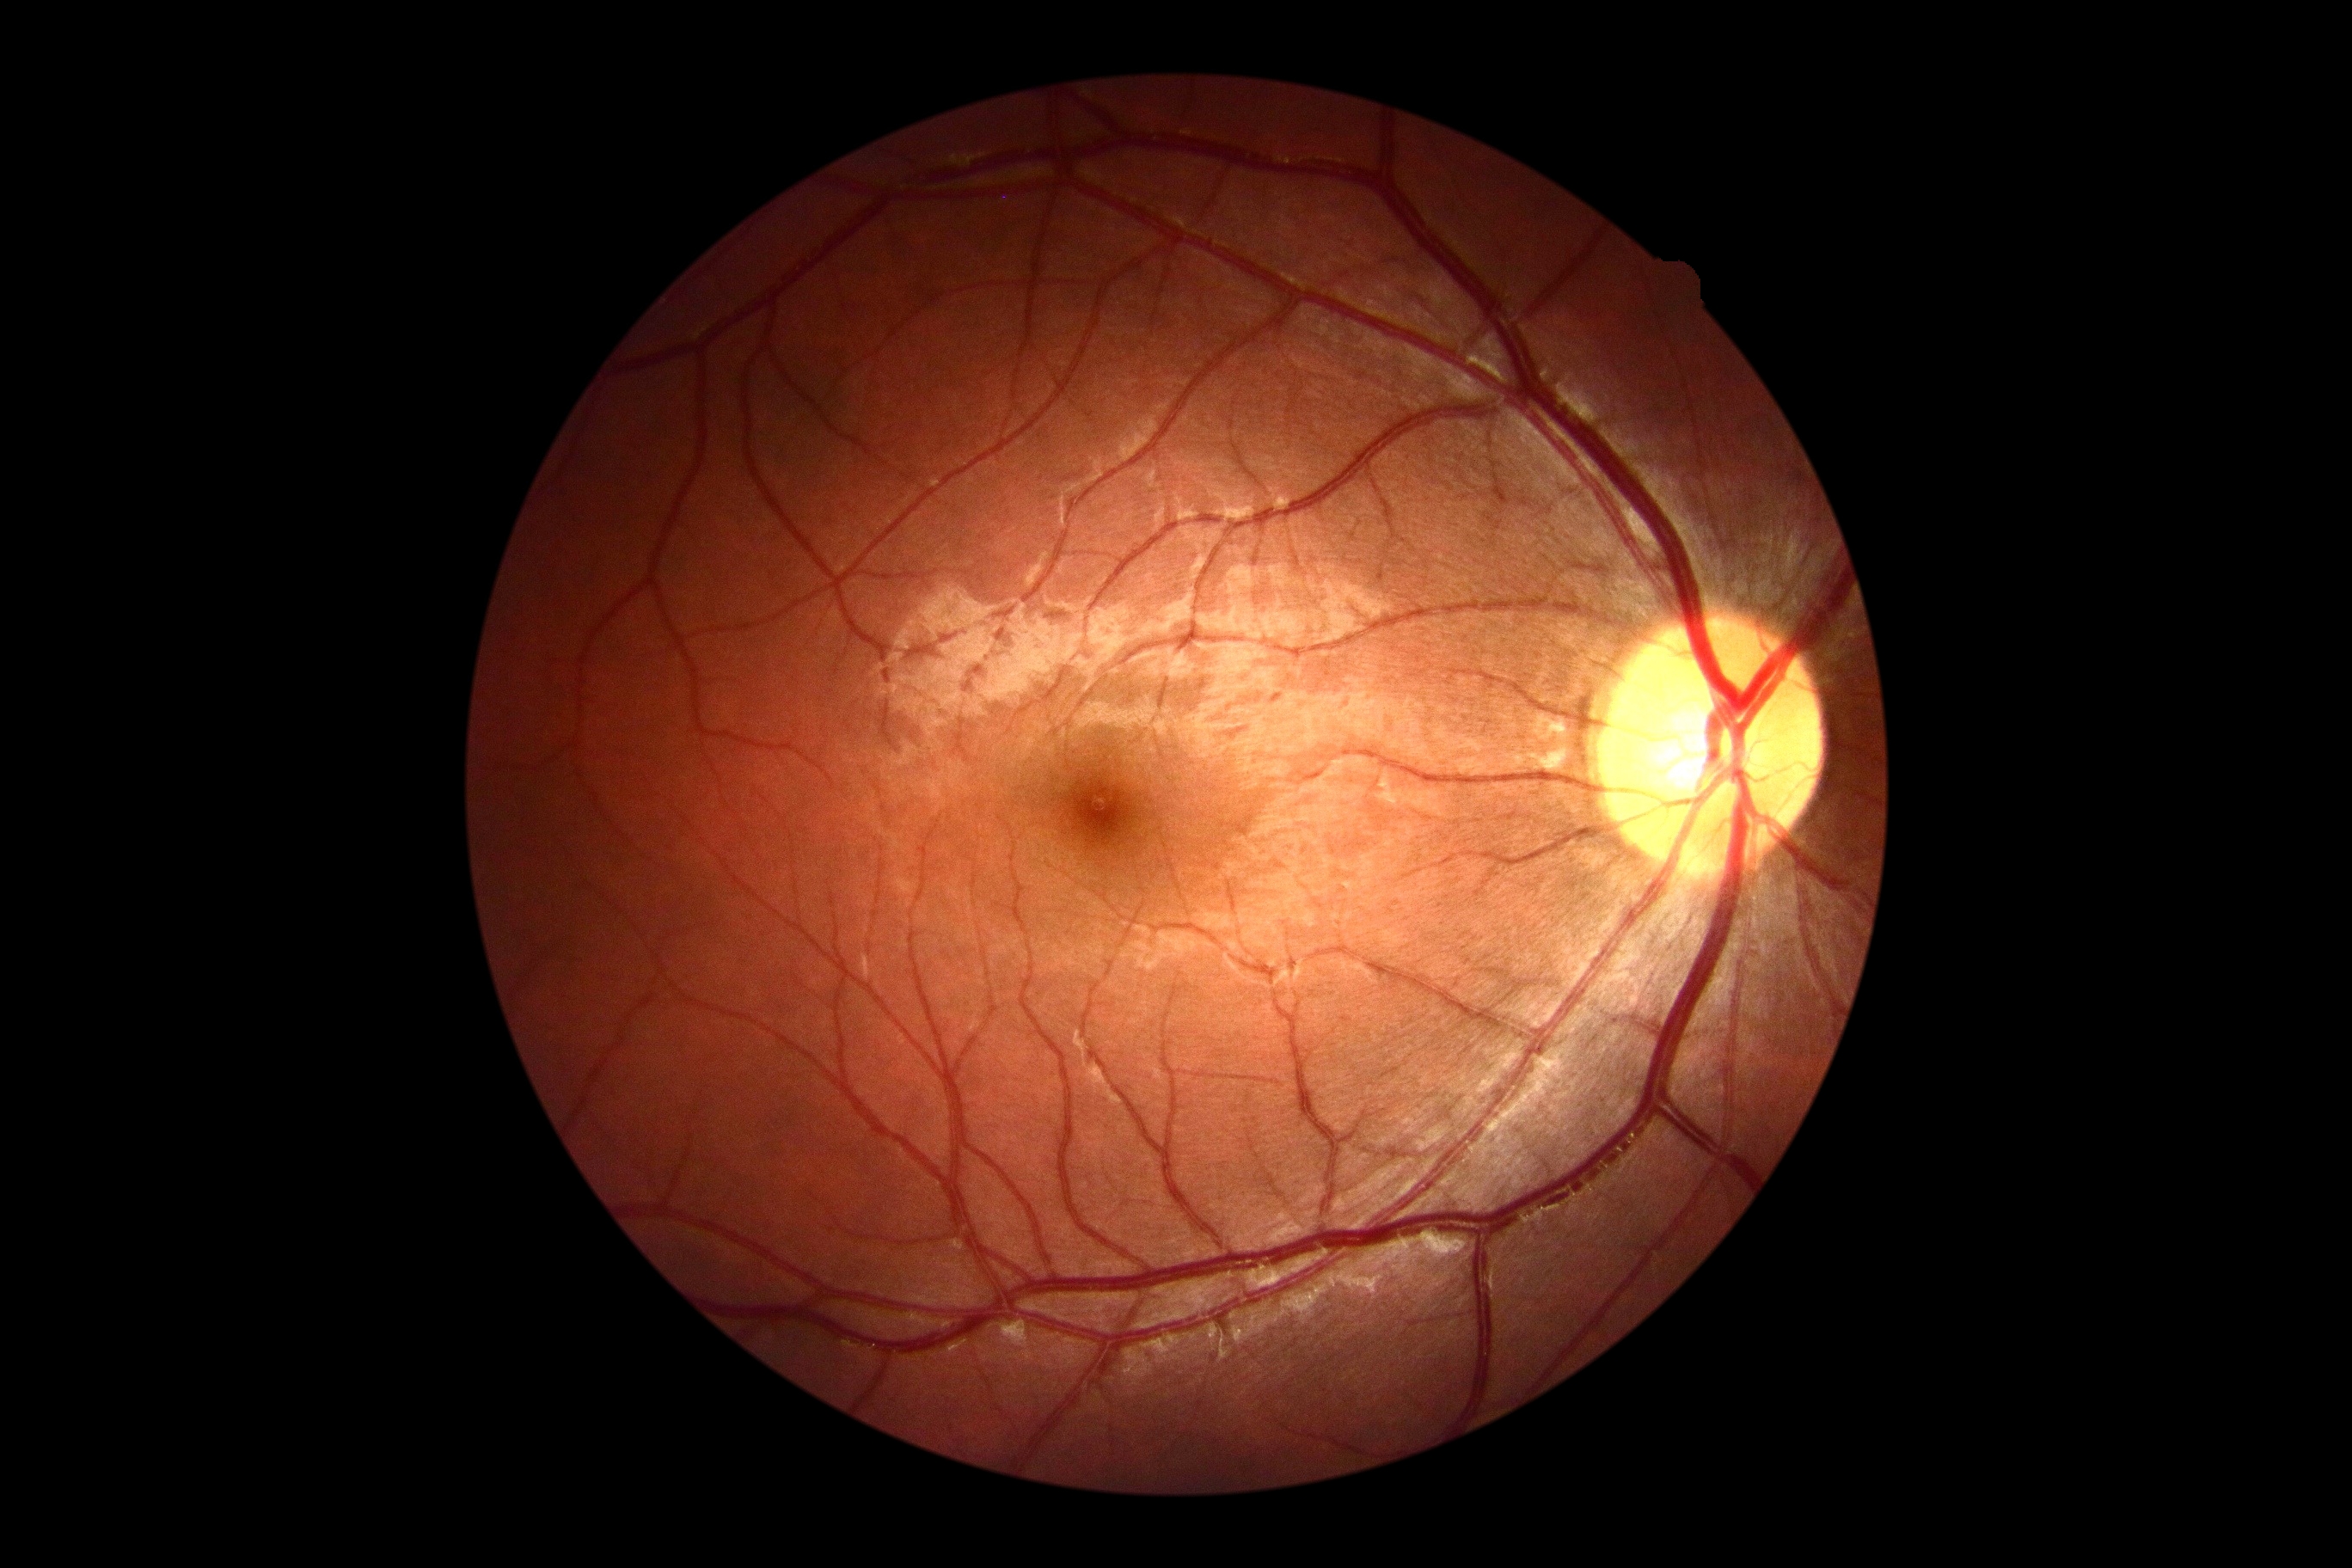
DR grade: 0 — no visible signs of diabetic retinopathy.